1932x1910px — 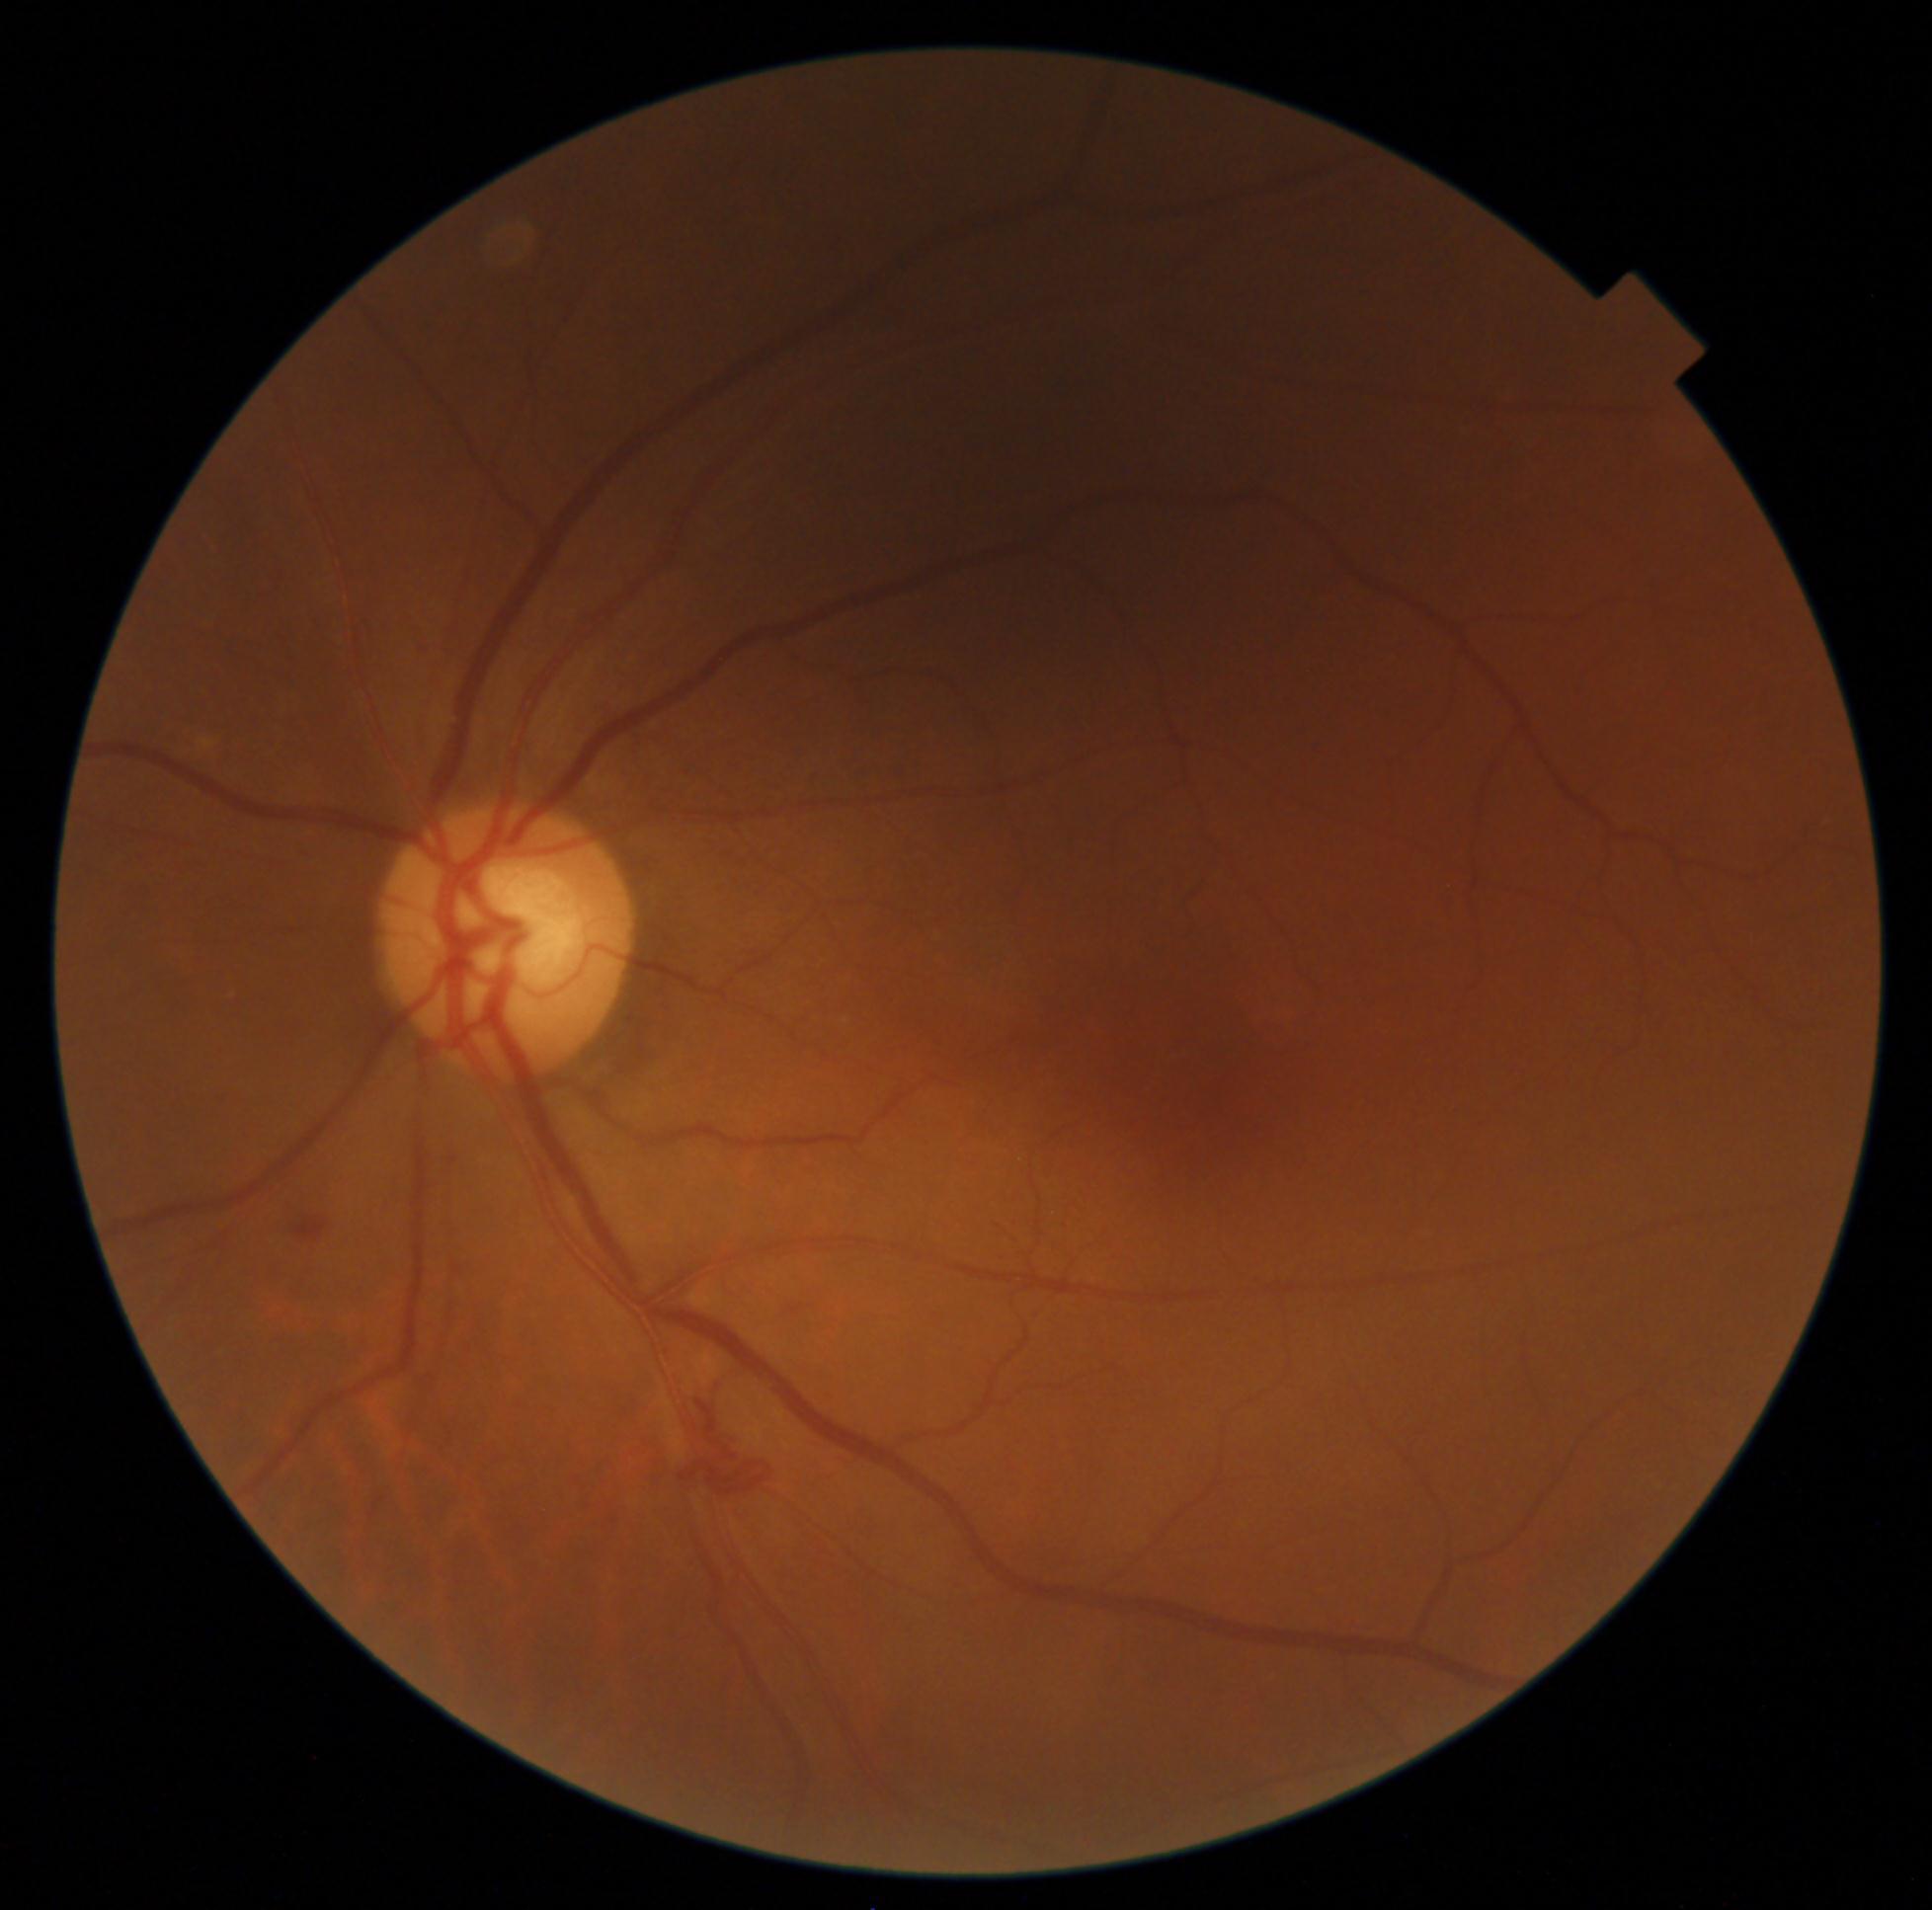

DR severity is grade 2.